Fundus photo.
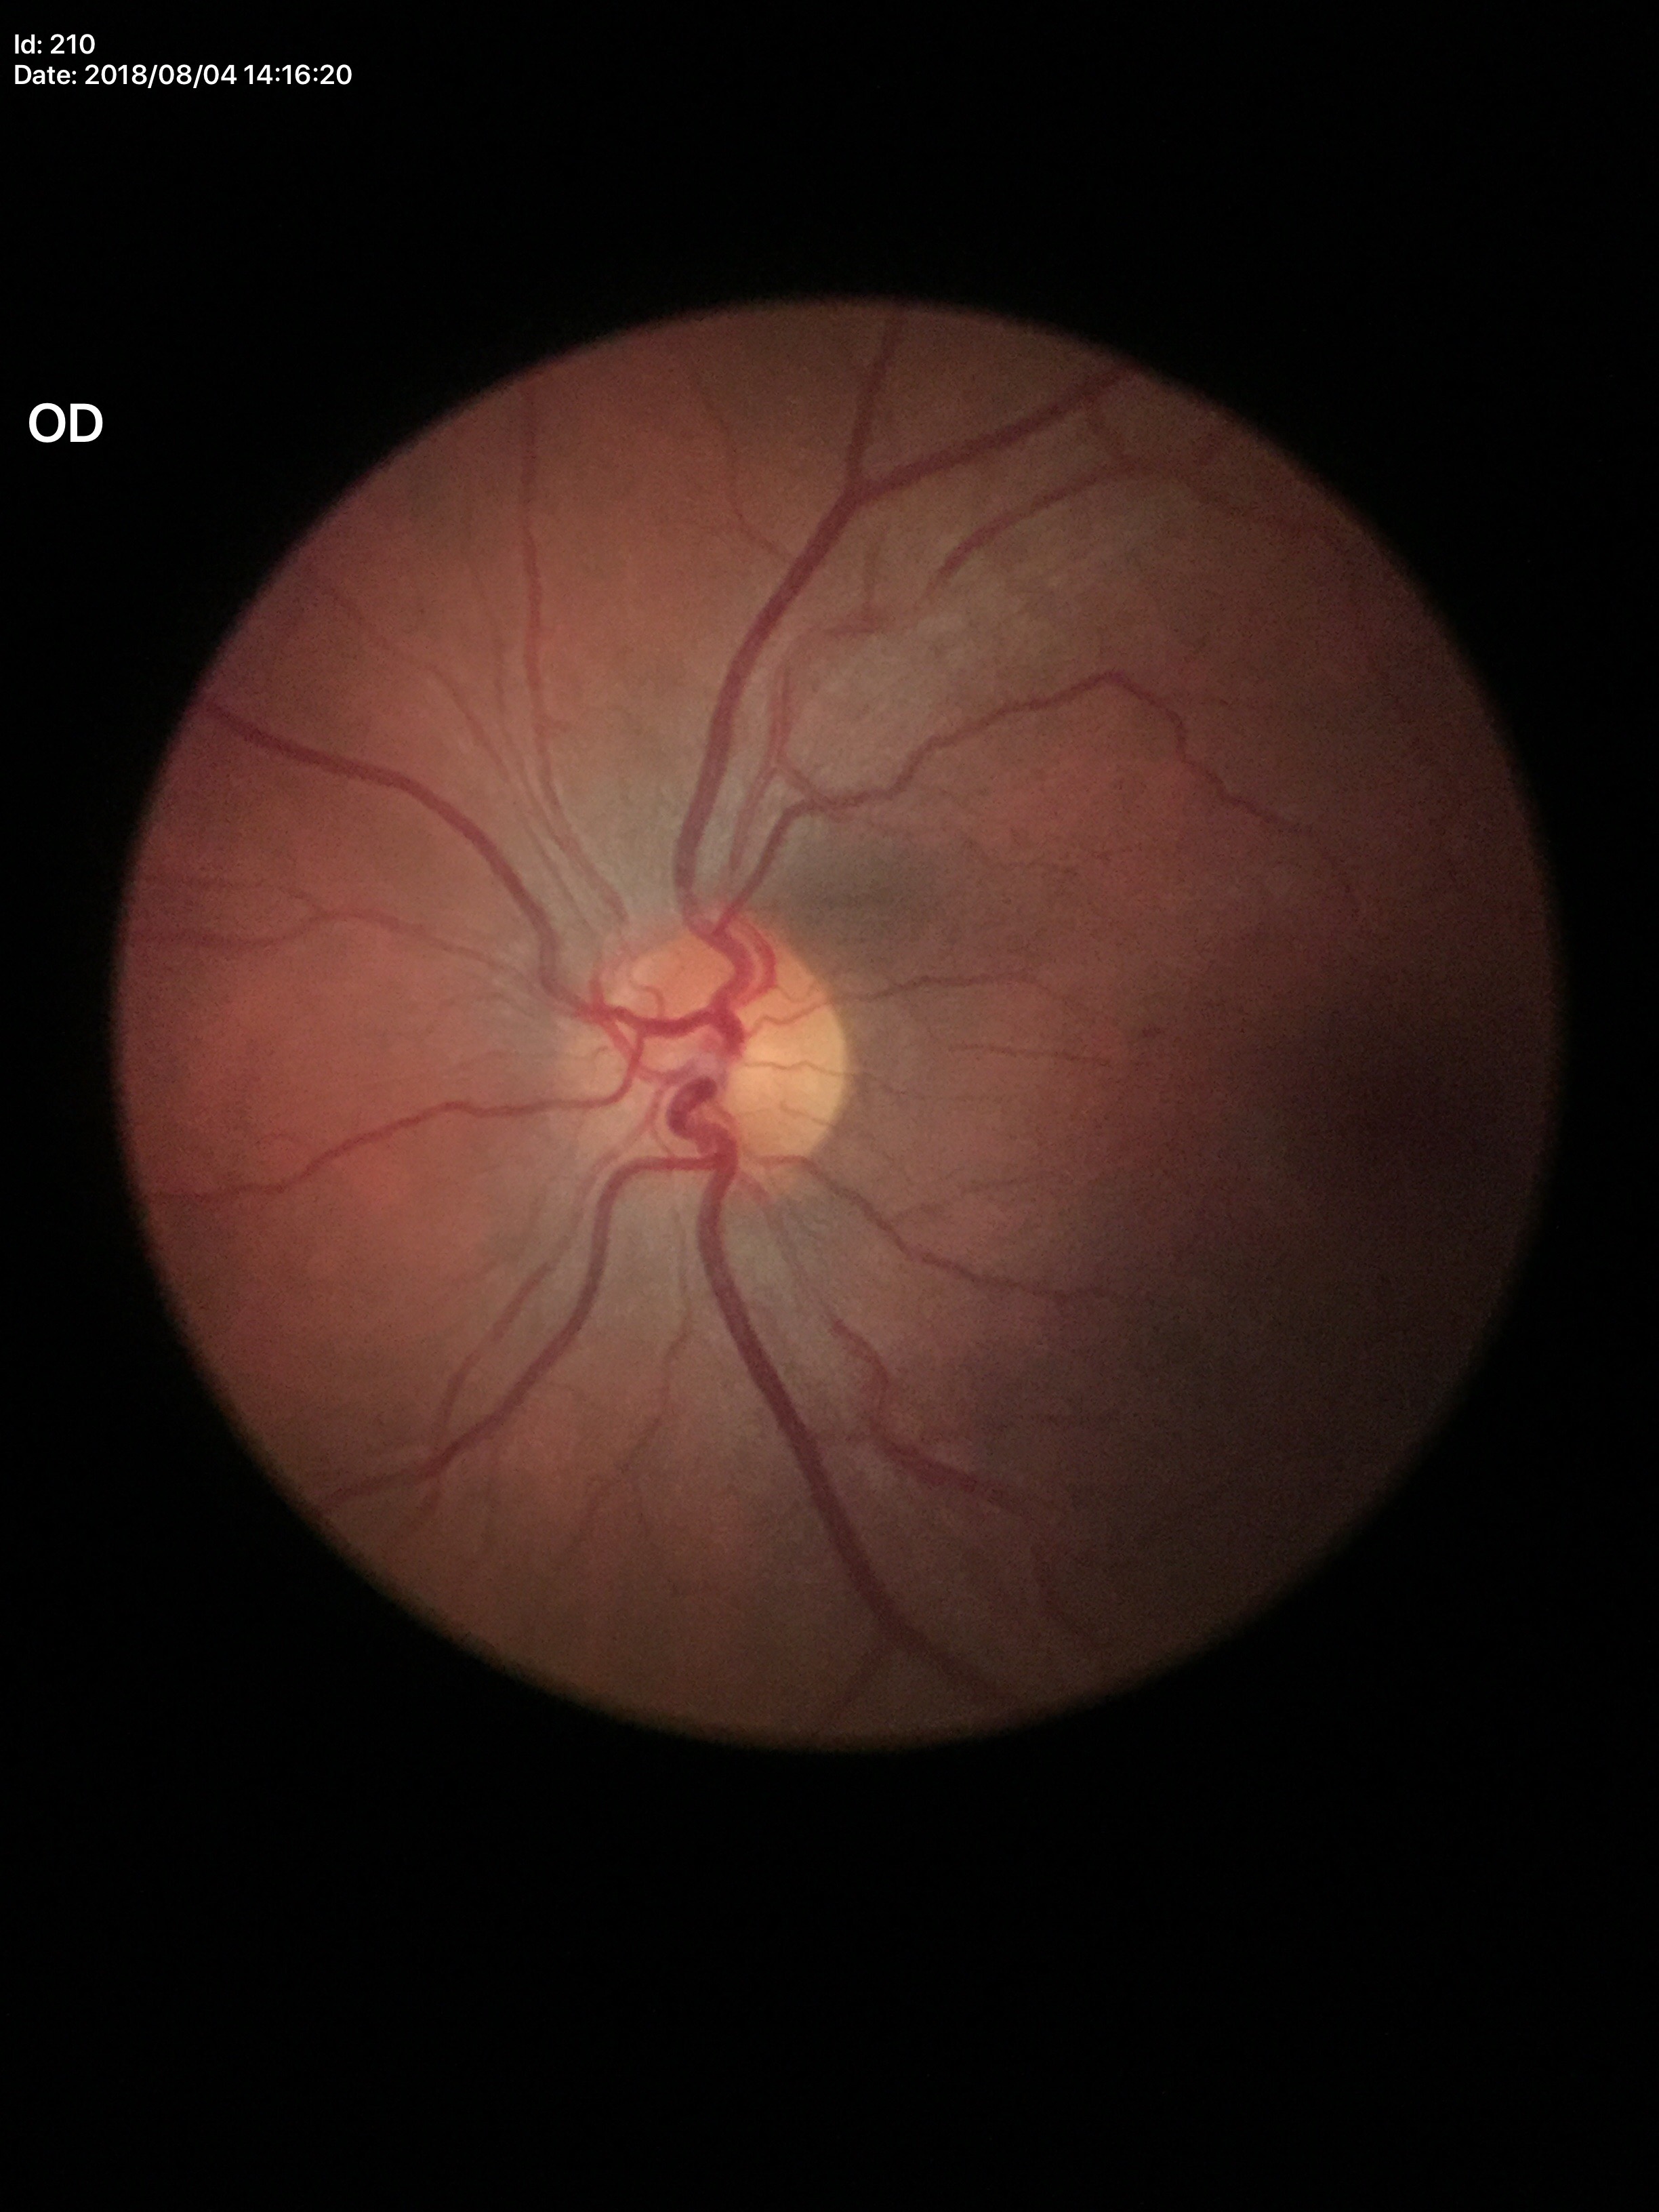
No glaucomatous findings. Vertical C/D ratio (VCDR) is 0.47.